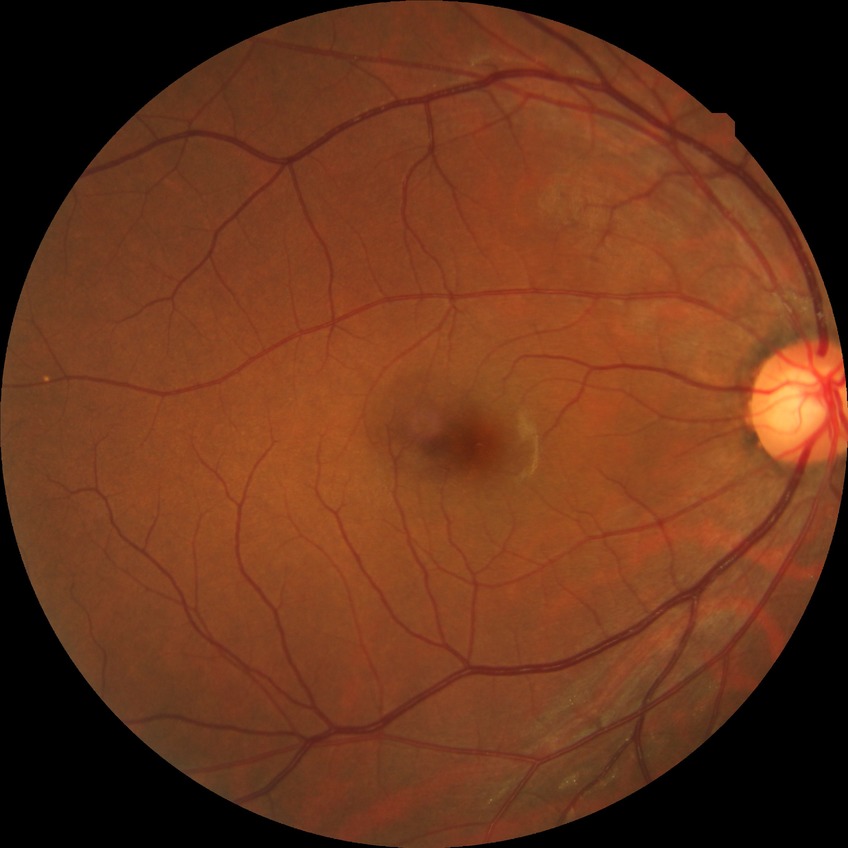 * retinopathy grade: no diabetic retinopathy